Infant wide-field fundus photograph; camera: Phoenix ICON (100° FOV) — 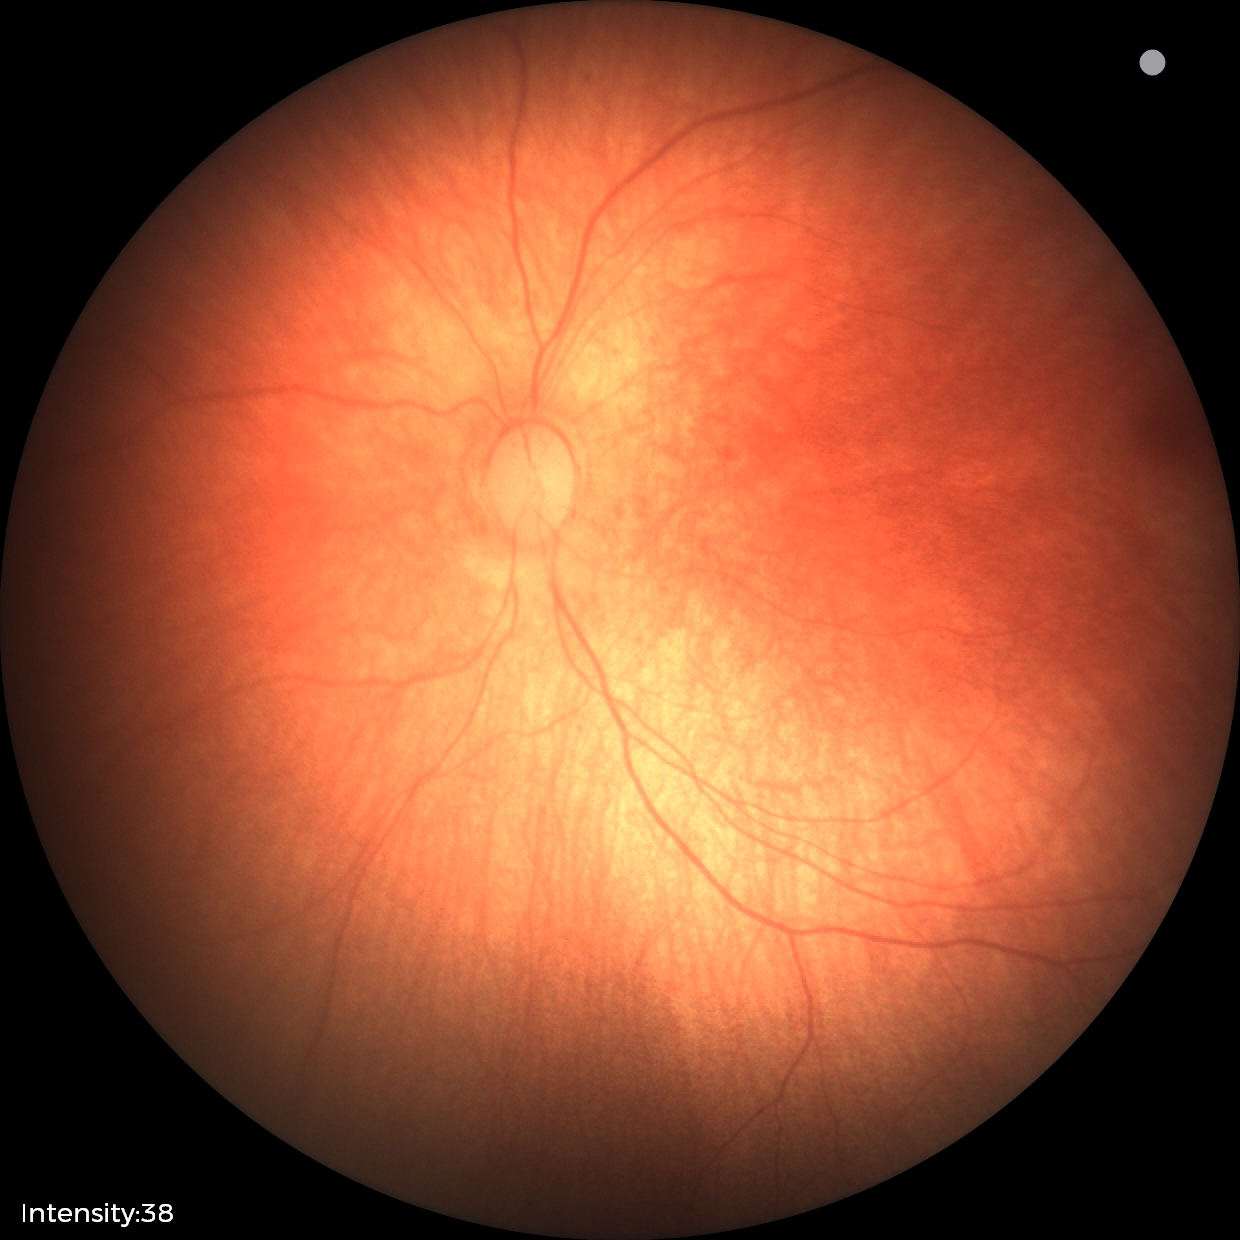 Screening diagnosis = no abnormalities